45° field of view; CFP; 1932x1910
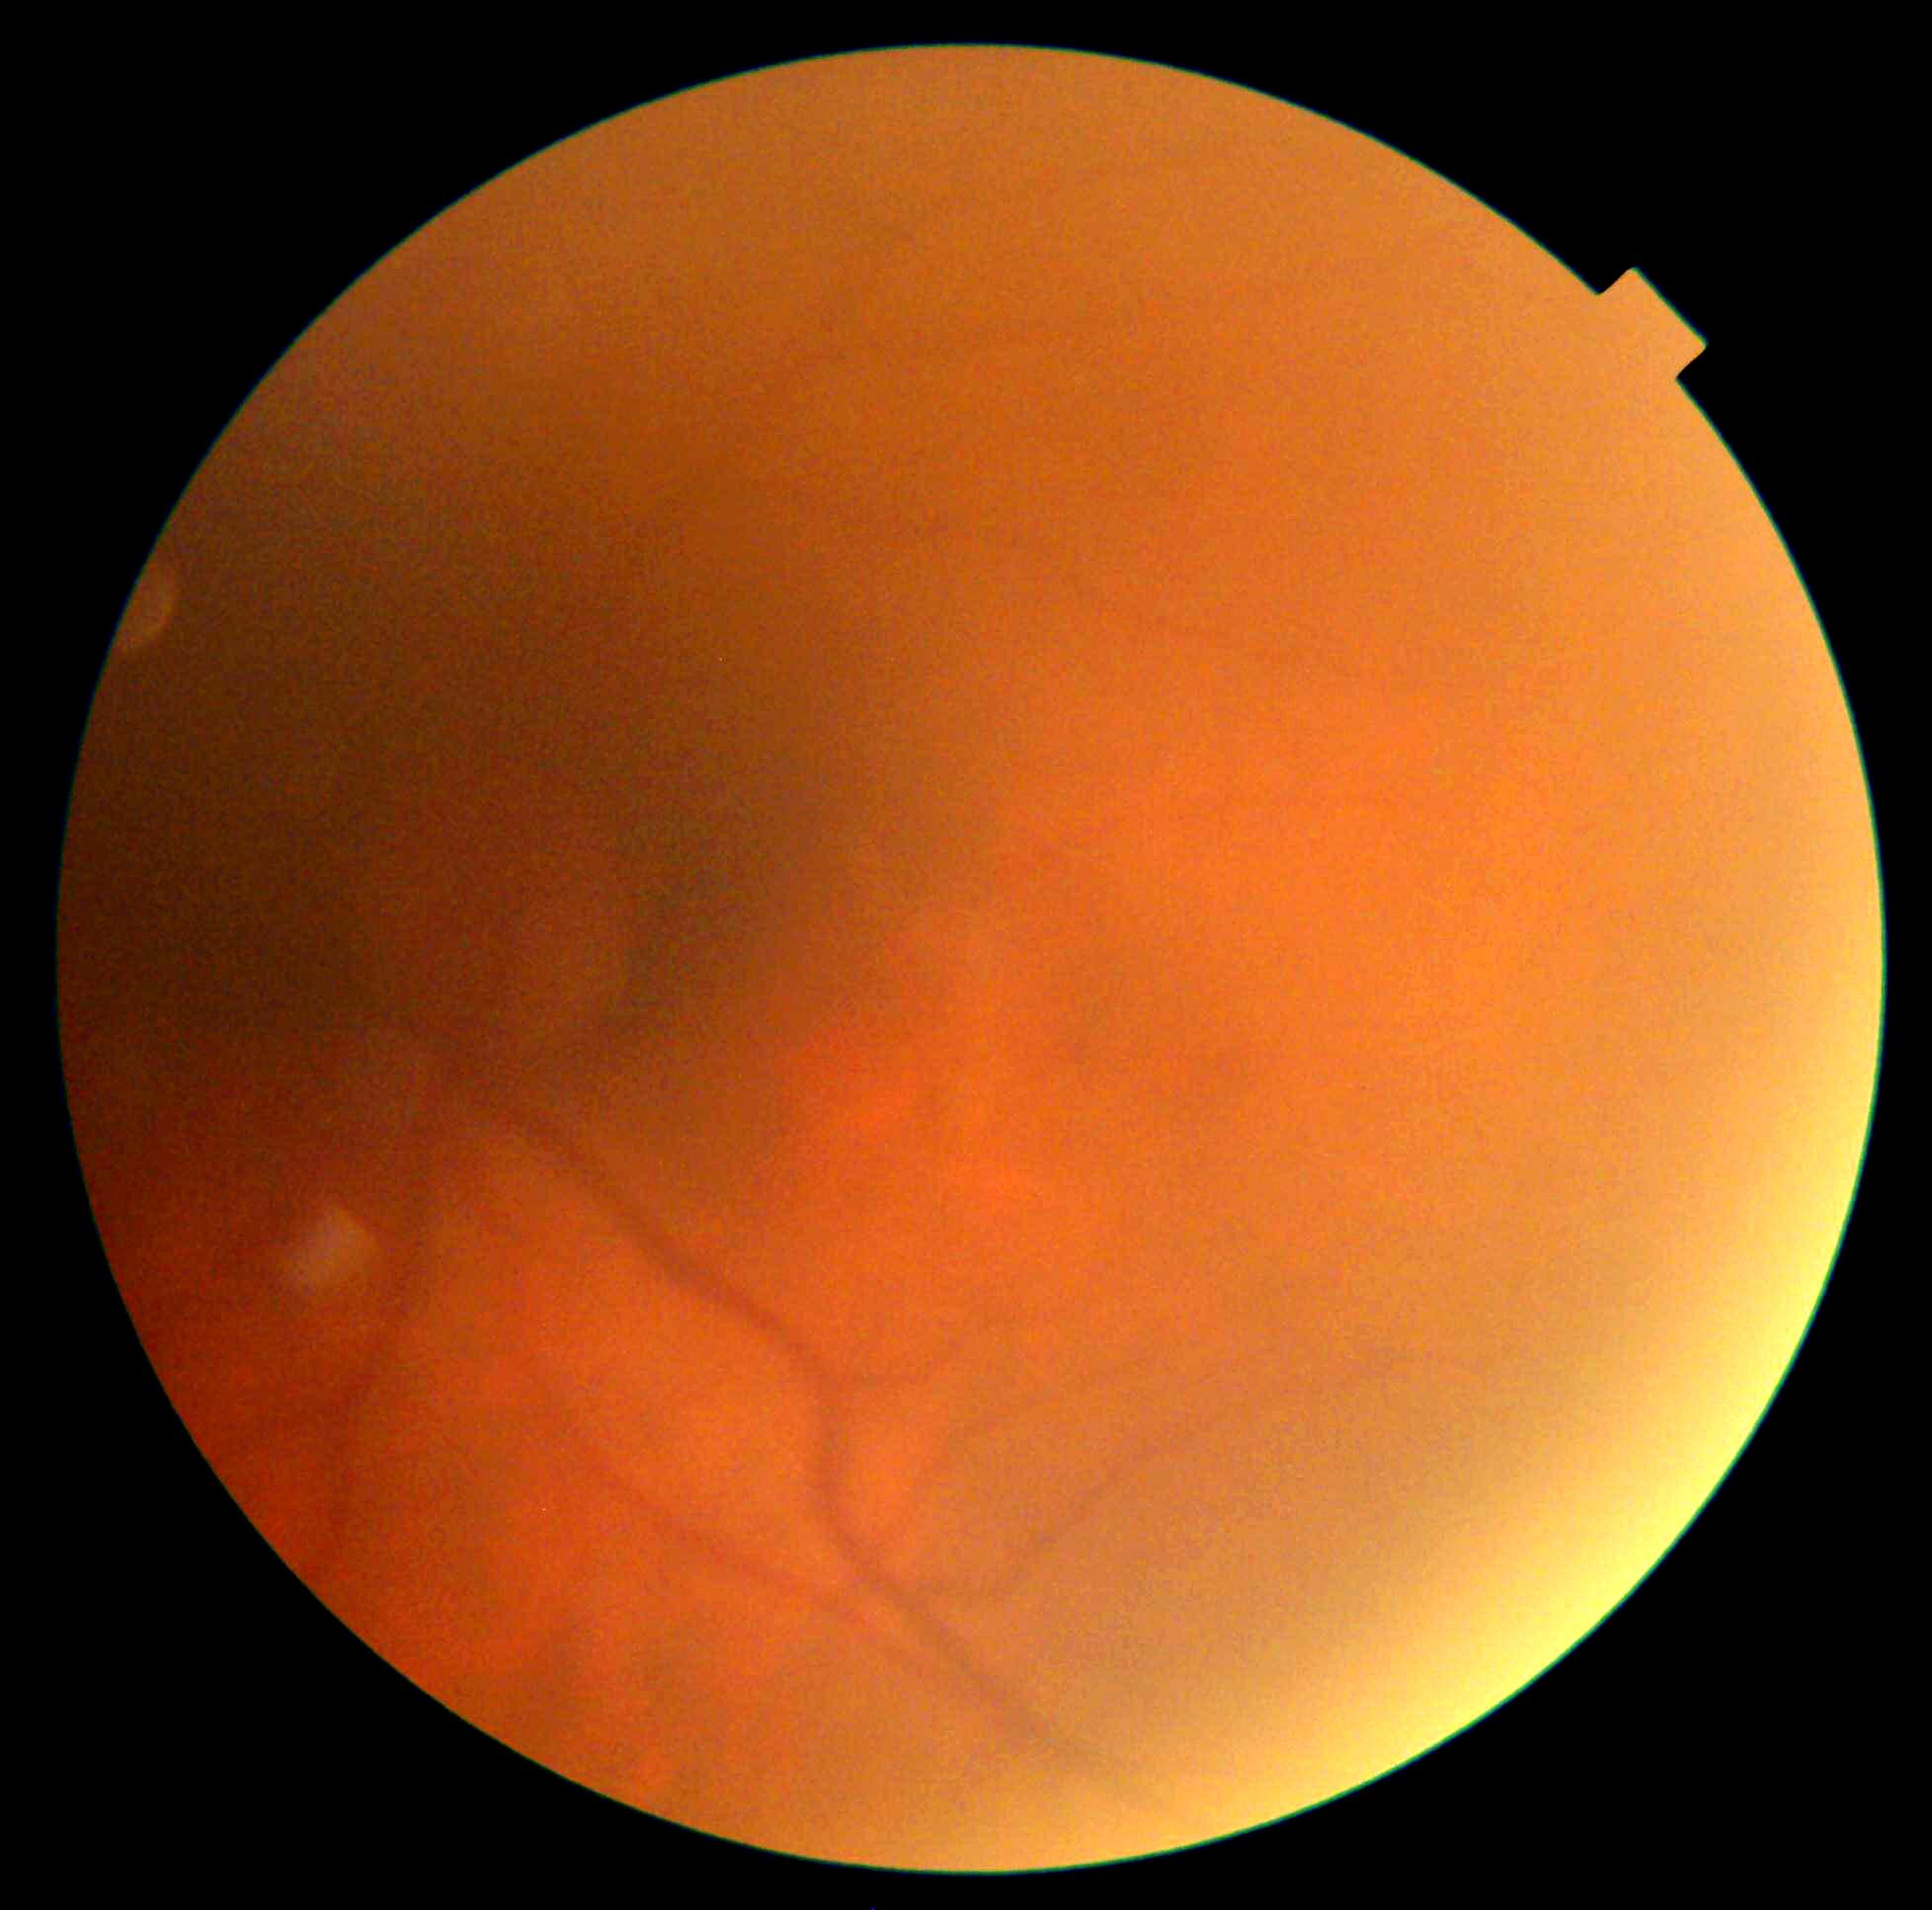 DR stage is 0.